FOV: 45 degrees
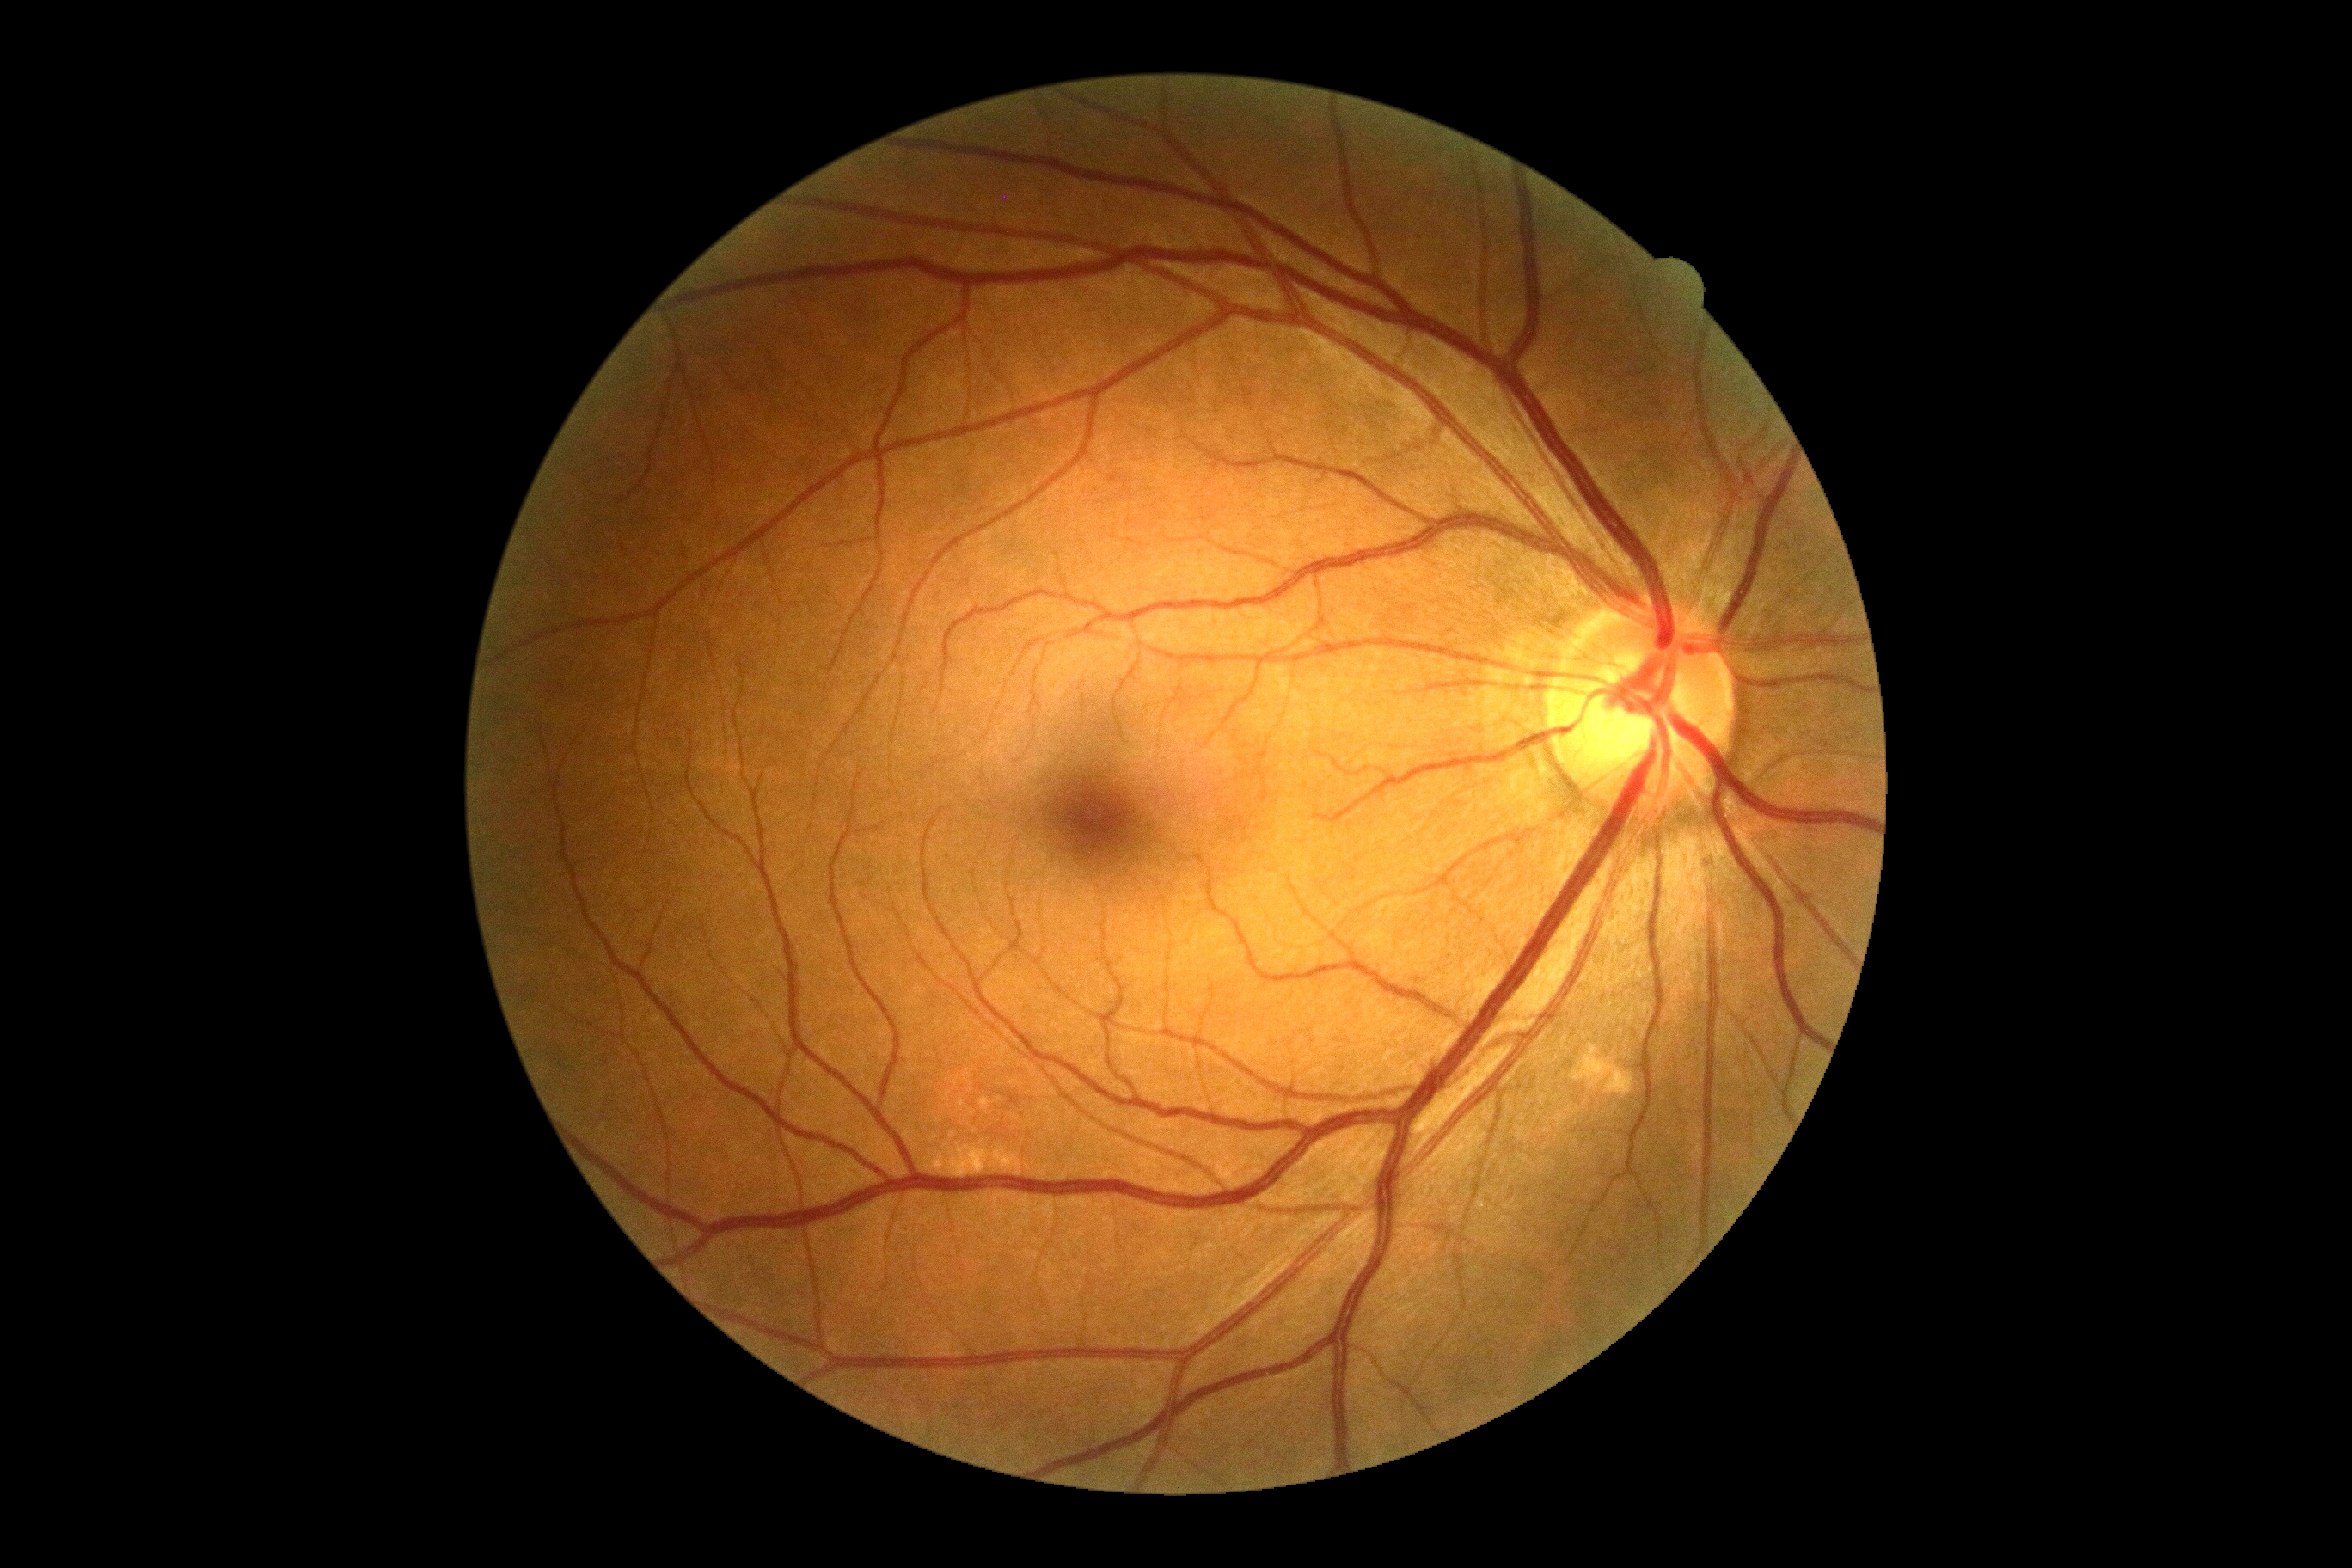

DR is grade 0 (no apparent retinopathy) — no visible signs of diabetic retinopathy.